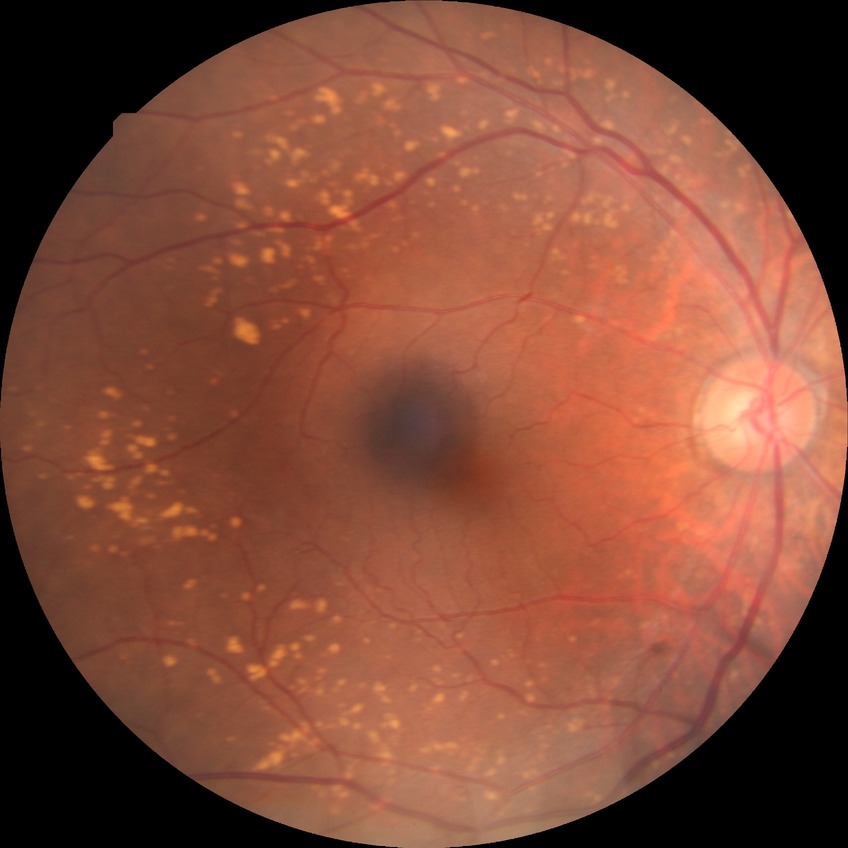
Diabetic retinopathy (DR) is NDR (no diabetic retinopathy).